Fundus photo
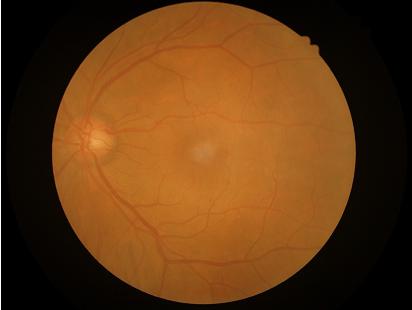 Illumination = satisfactory; Overall = adequate; Contrast = good; Focus = good.